2352x1568px, FOV: 45 degrees.
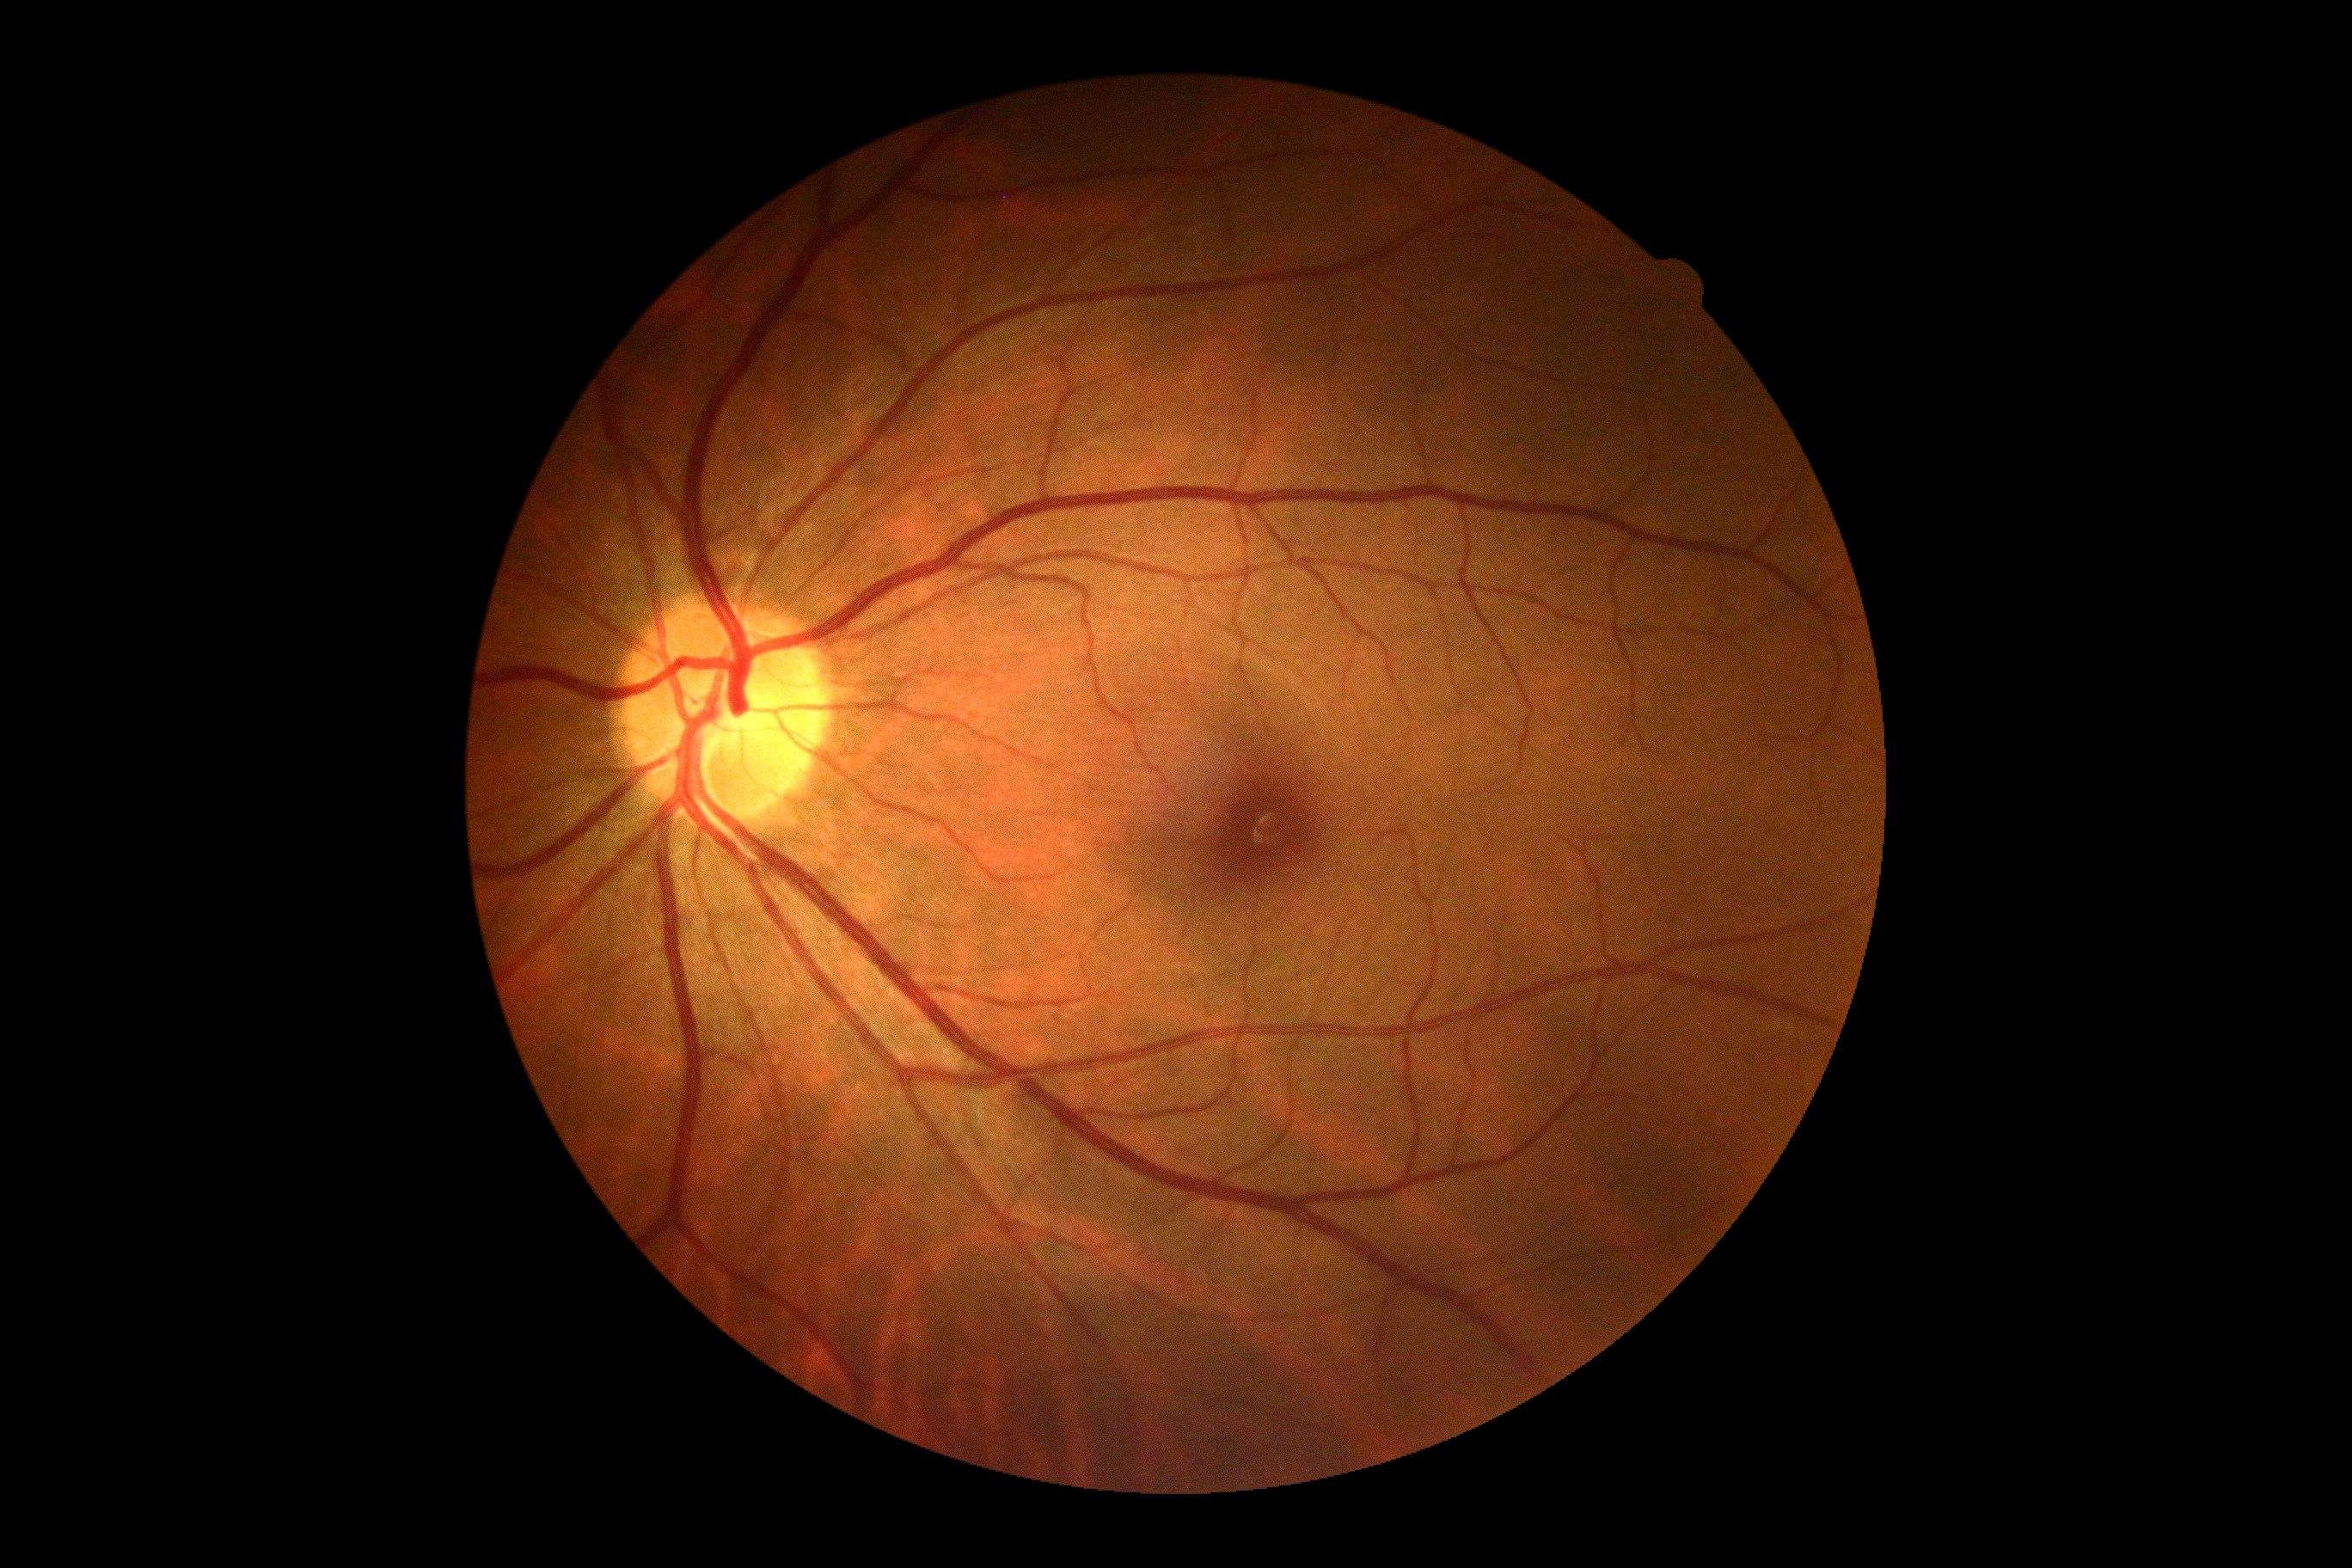 Findings:
– DR stage: no apparent retinopathy (grade 0)